Retinal fundus photograph; image size 1932x1916; 45° FOV
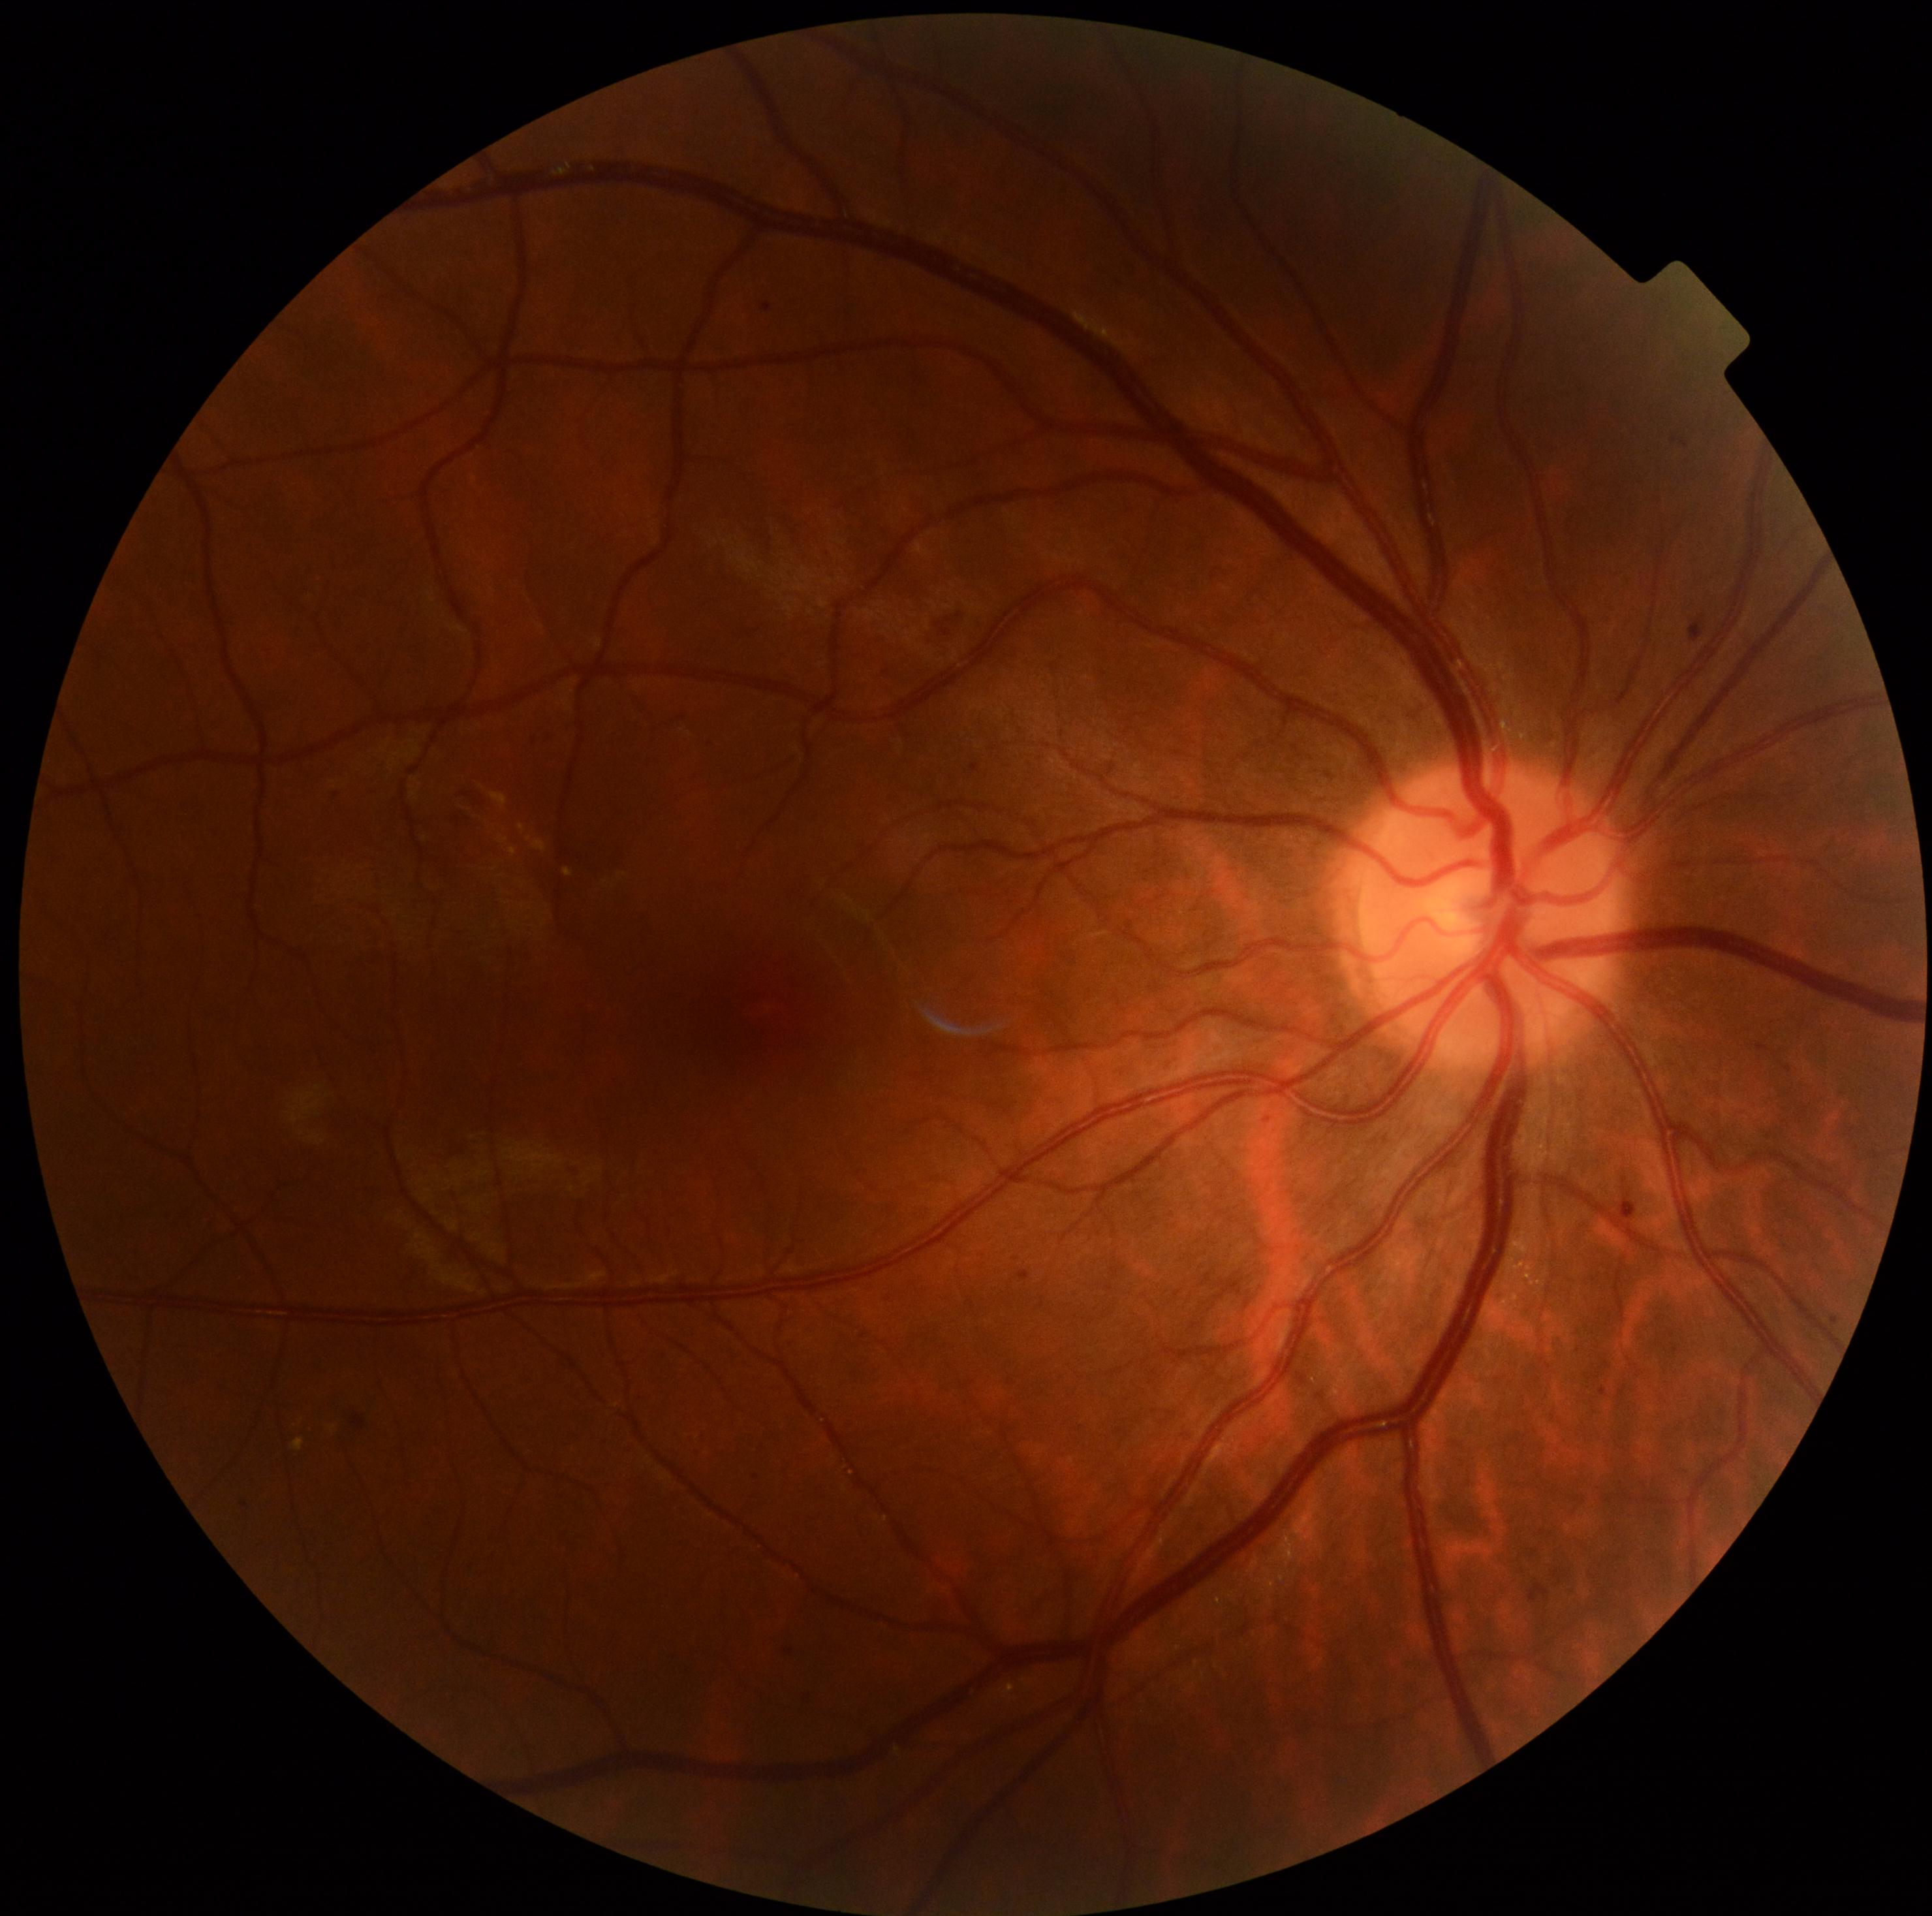 diabetic retinopathy grade@2 (moderate NPDR) — more than just microaneurysms but less than severe NPDR.